45° FOV:
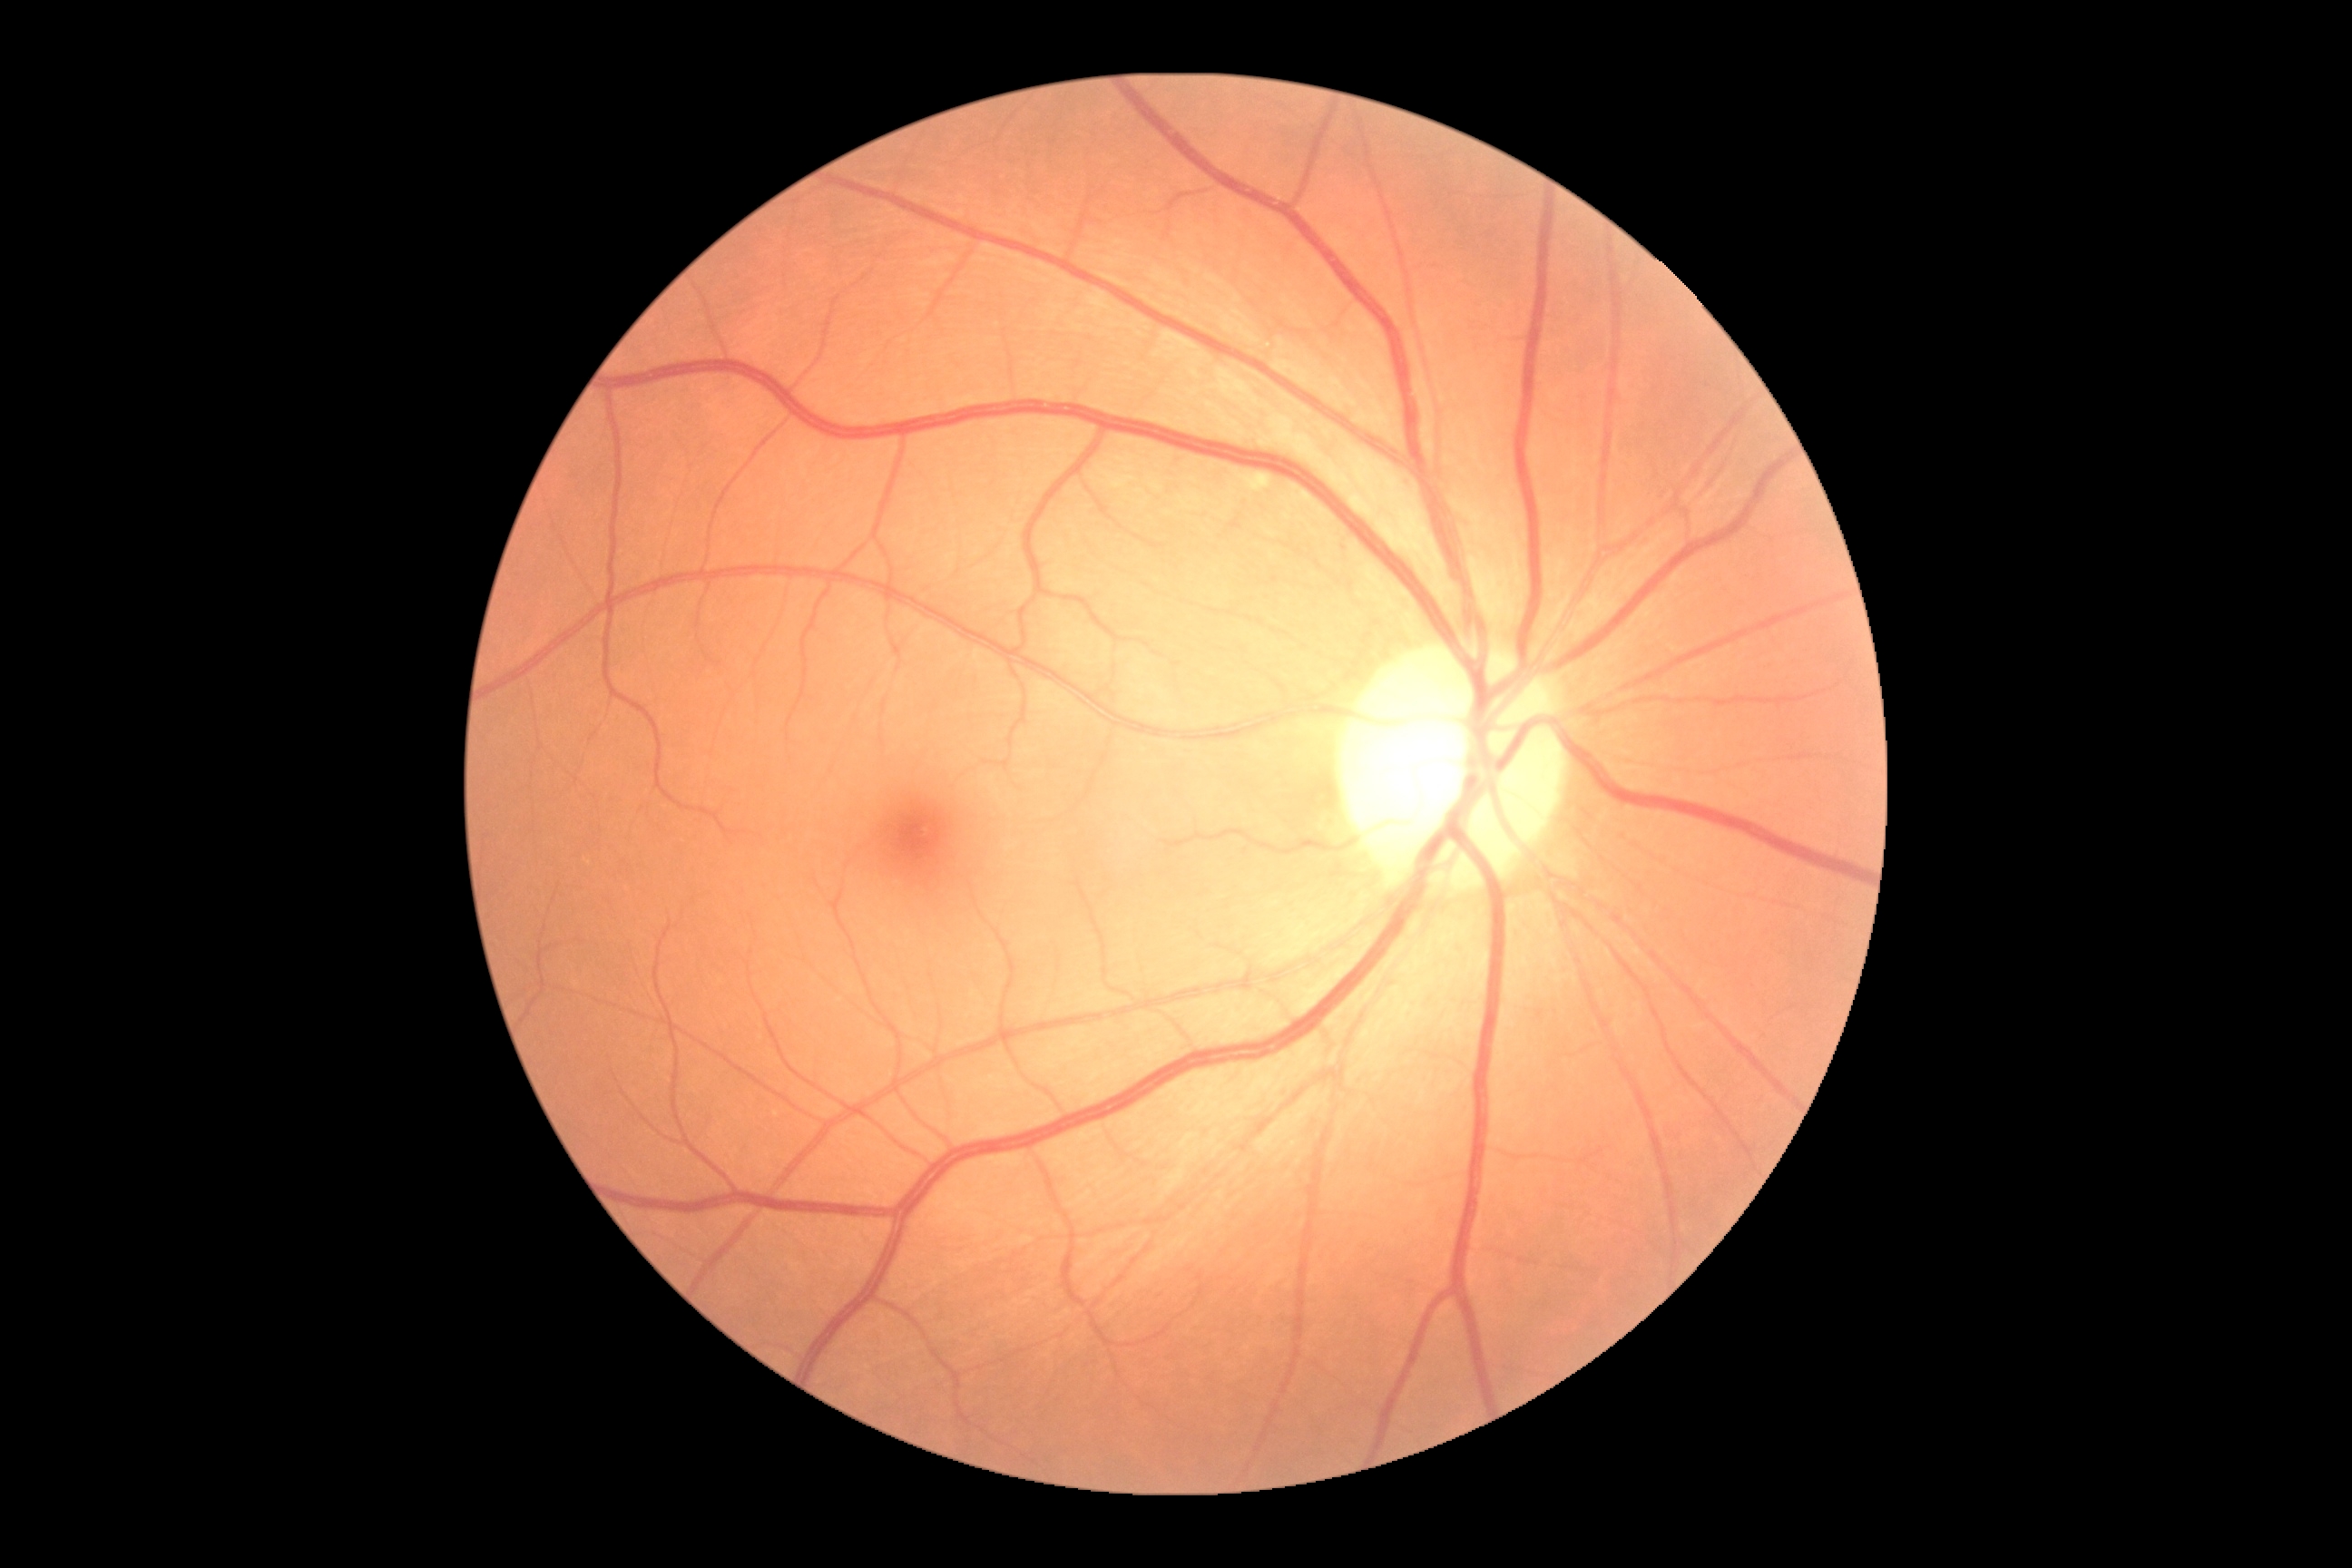
diabetic retinopathy grade: 0/4; DR impression: no apparent DR.